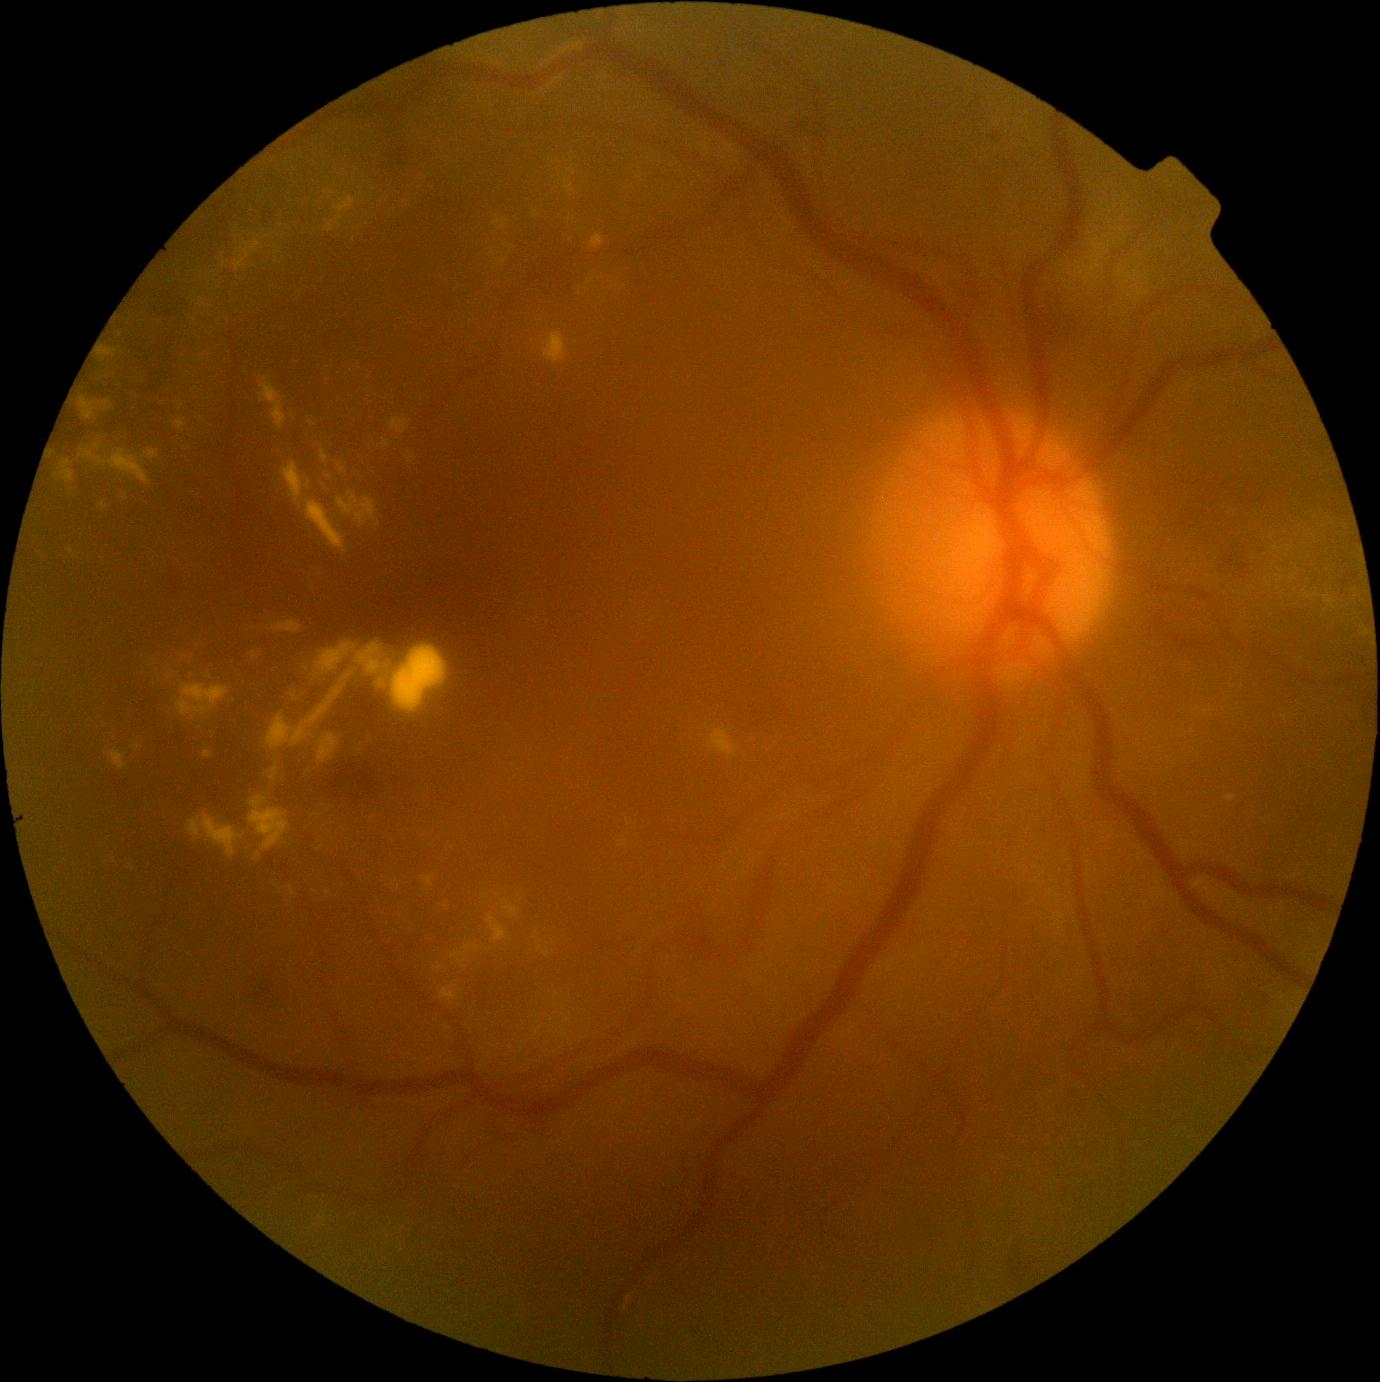
DR severity: grade 2 (moderate NPDR); non-proliferative diabetic retinopathy
Representative lesions:
• EXs (more not shown): l=1084, t=242, r=1111, b=271, l=422, t=874, r=436, b=888, l=451, t=952, r=467, b=968, l=273, t=621, r=303, b=633, l=534, t=211, r=538, b=219, l=305, t=501, r=347, b=554, l=68, t=548, r=76, b=557, l=543, t=951, r=552, b=958, l=250, t=651, r=262, b=663, l=338, t=496, r=378, b=527, l=1123, t=274, r=1135, b=283
• Additional small EXs near point(201, 300), point(98, 446), point(1294, 579), point(103, 504), point(1192, 732), point(329, 478), point(326, 825)